848x848px: 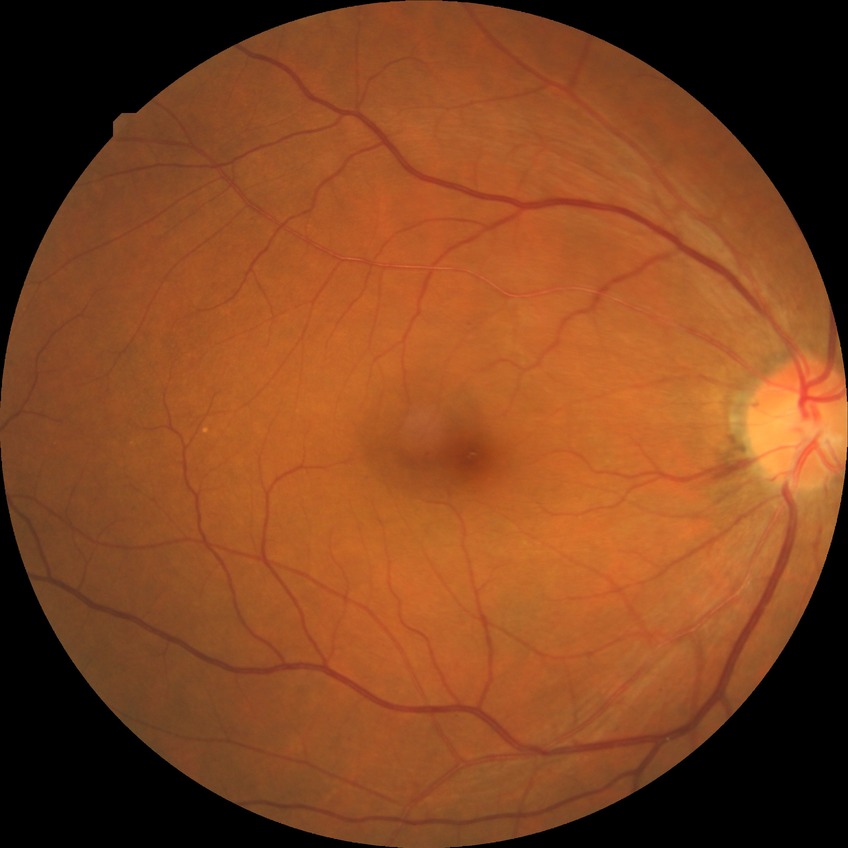
diabetic retinopathy (DR): NDR (no diabetic retinopathy).